2350x1568: 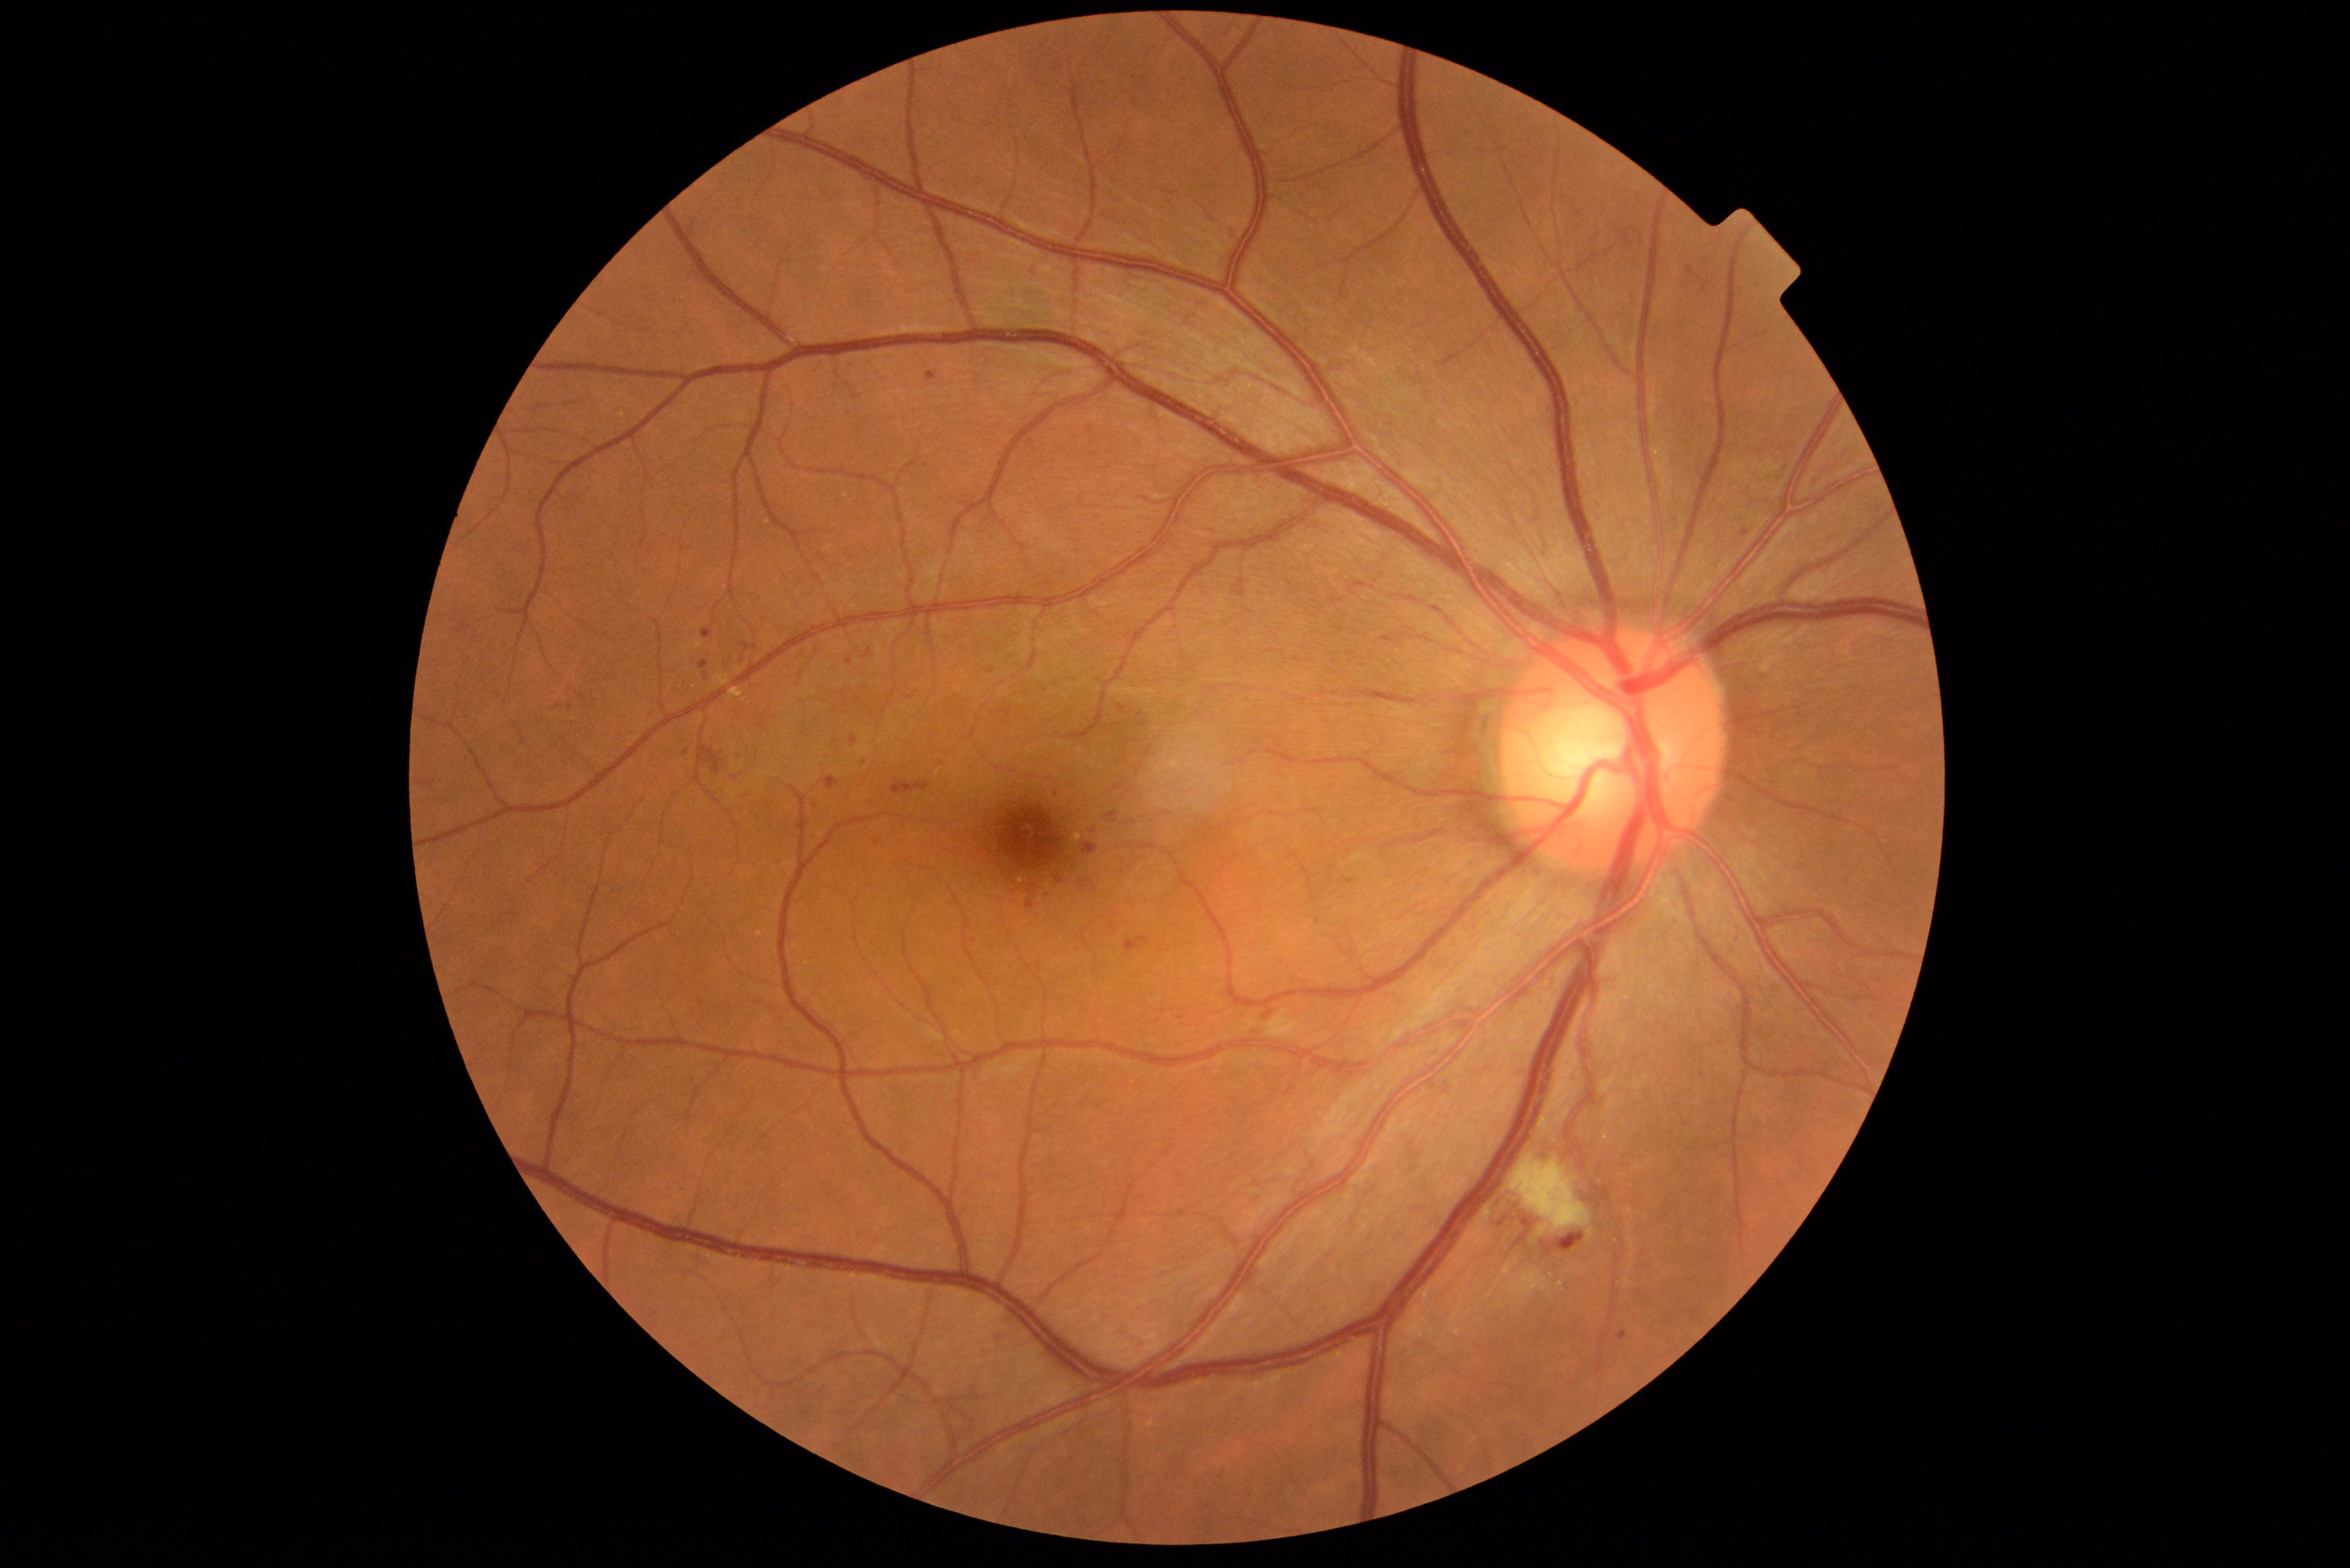
  dr_grade: 2 (moderate NPDR)